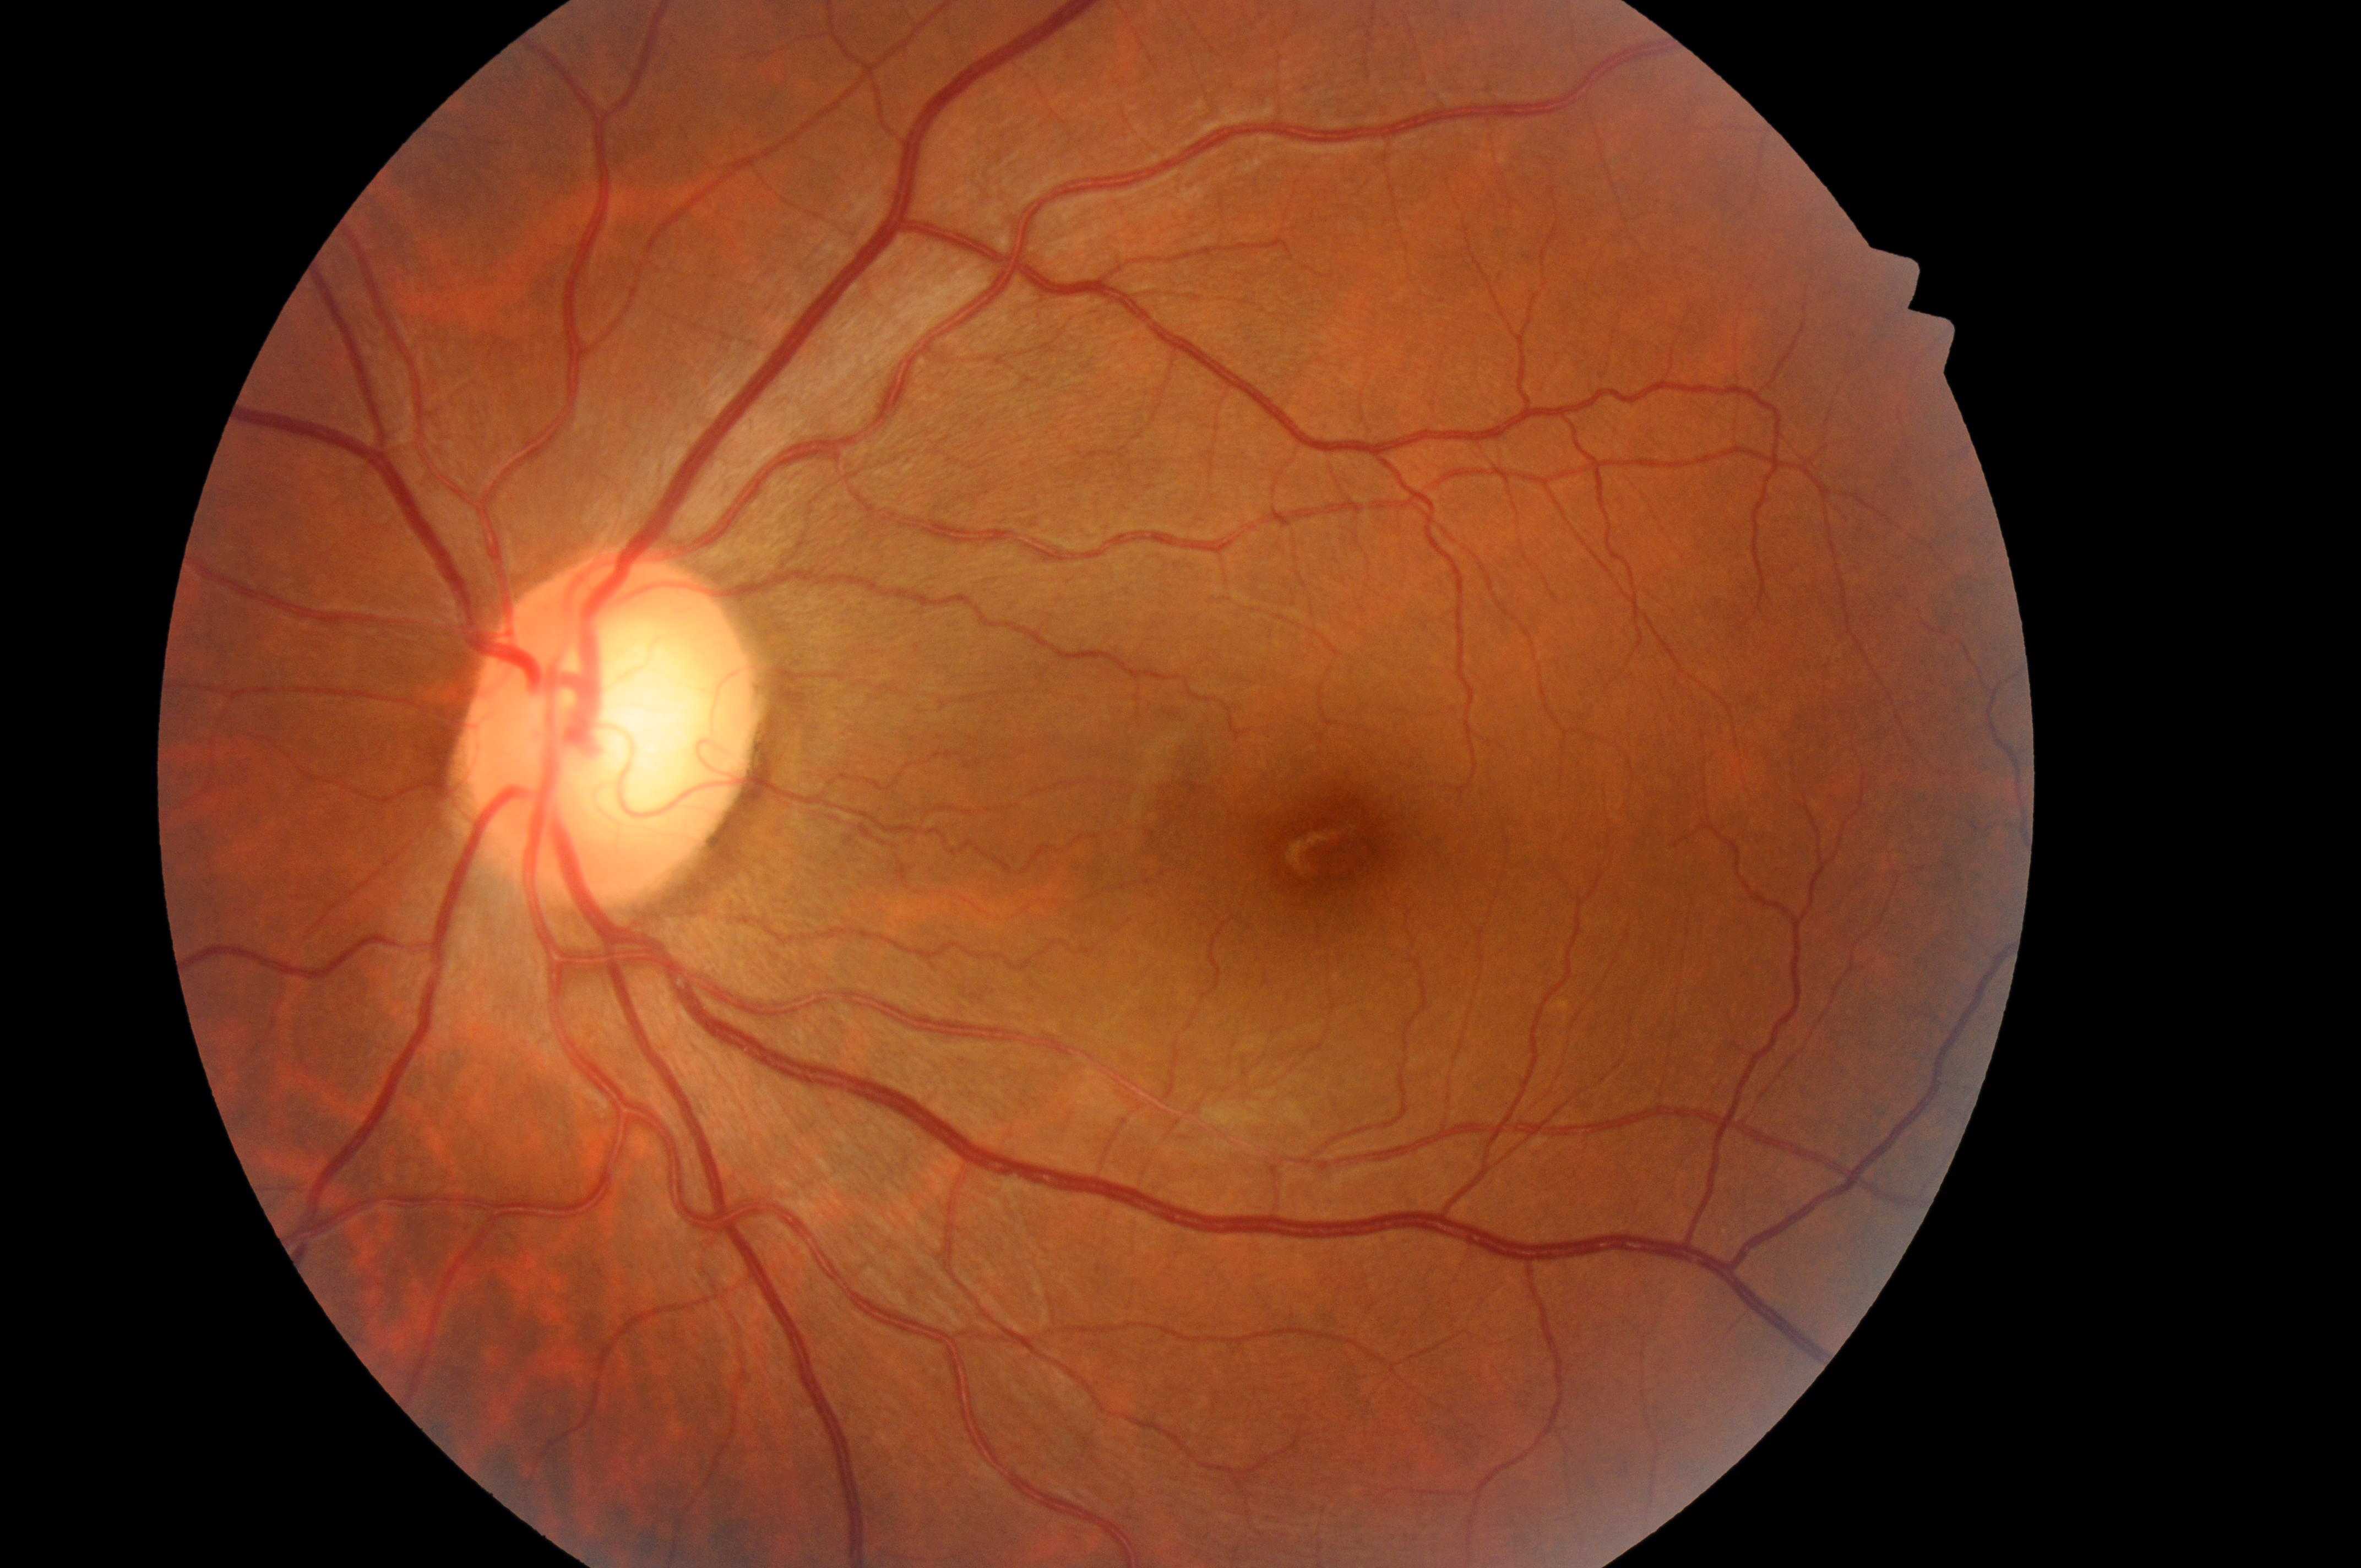

The fovea is at 1336px, 850px. DR grade: 0. DME risk is 0. Optic disk located at 602px, 742px. The image shows the left eye.